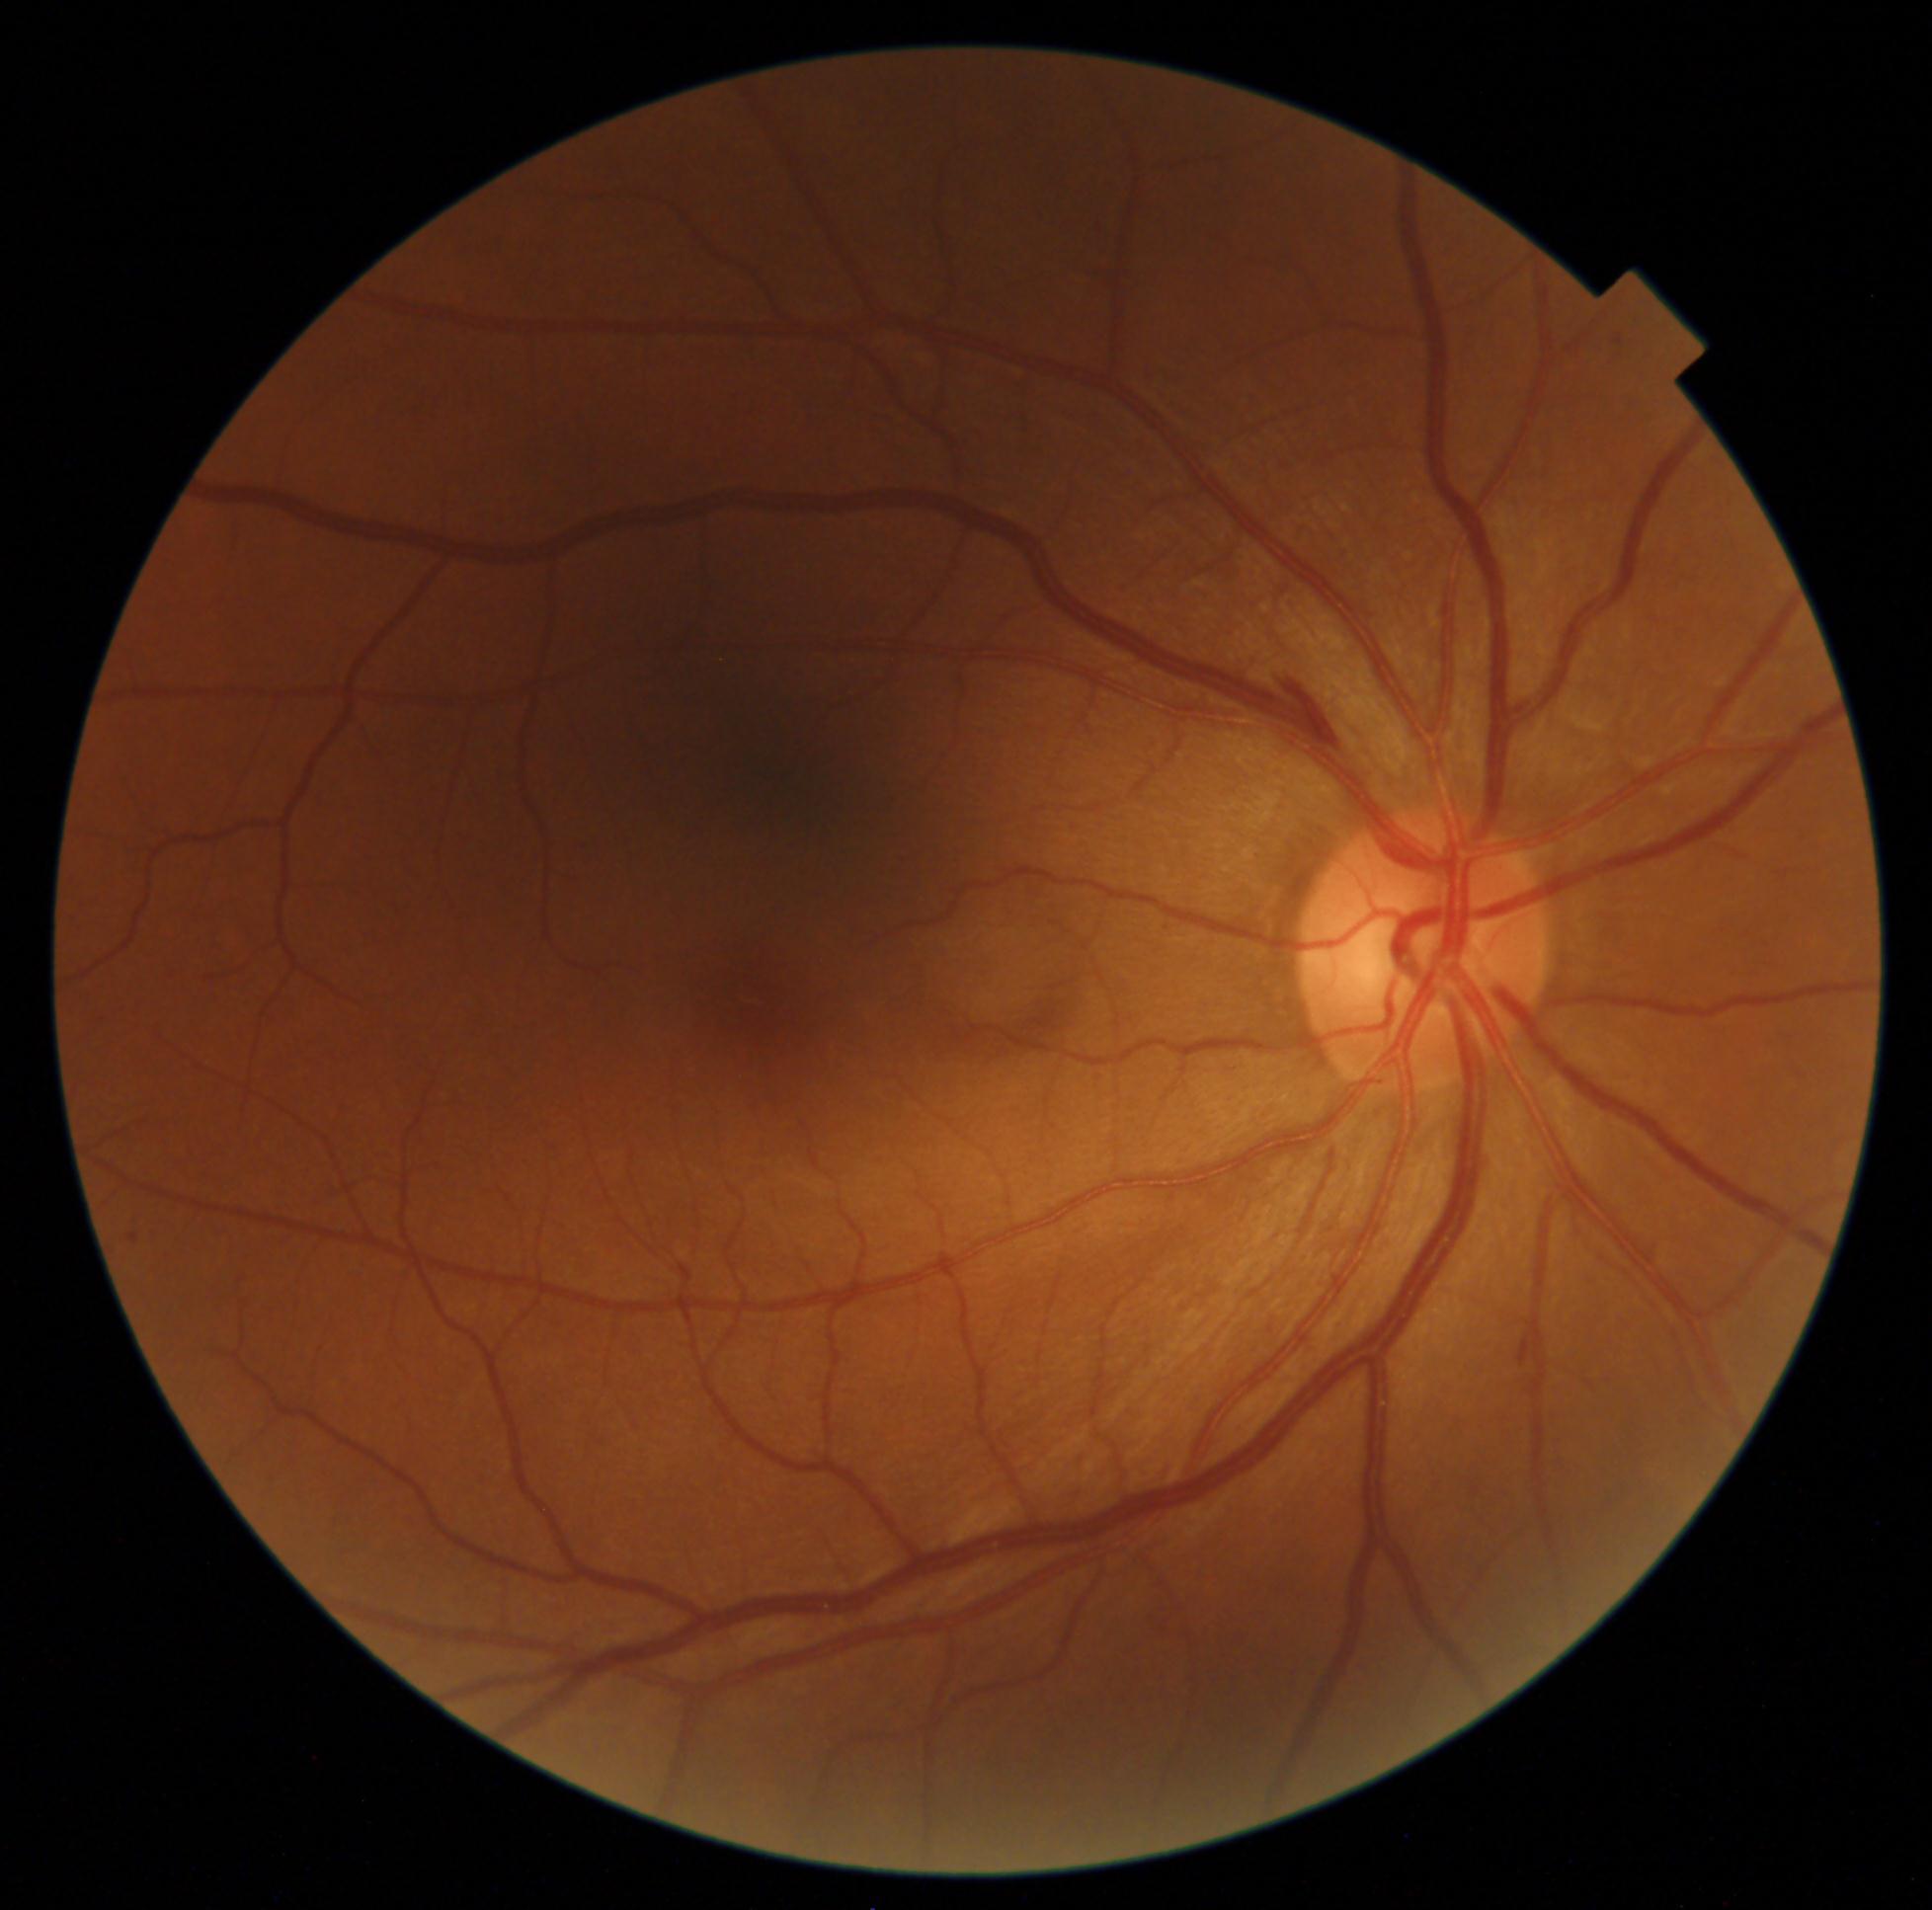 • retinopathy: 2/4